45-degree field of view:
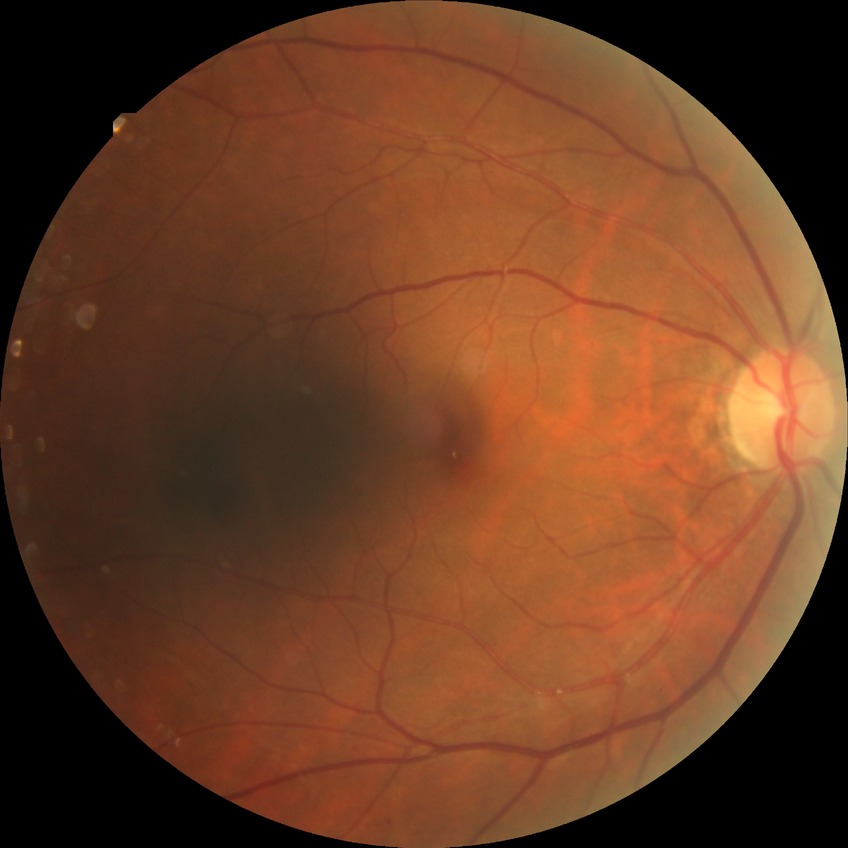

Diabetic retinopathy (DR) is NDR (no diabetic retinopathy).